ONH-centered crop from a color fundus image, 35° field of view before cropping.
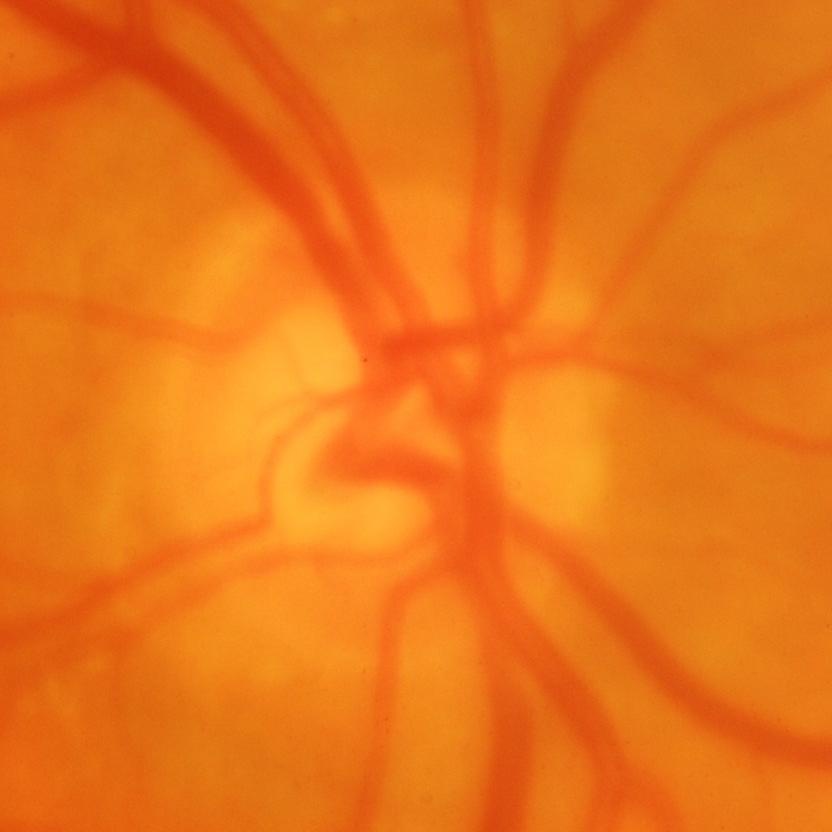
Glaucomatous optic neuropathy is present. Glaucoma status = glaucomatous changes.